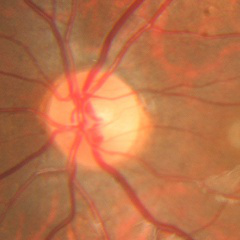

Demonstrates no evidence of glaucoma.